Pediatric retinal photograph (wide-field). 1440 by 1080 pixels.
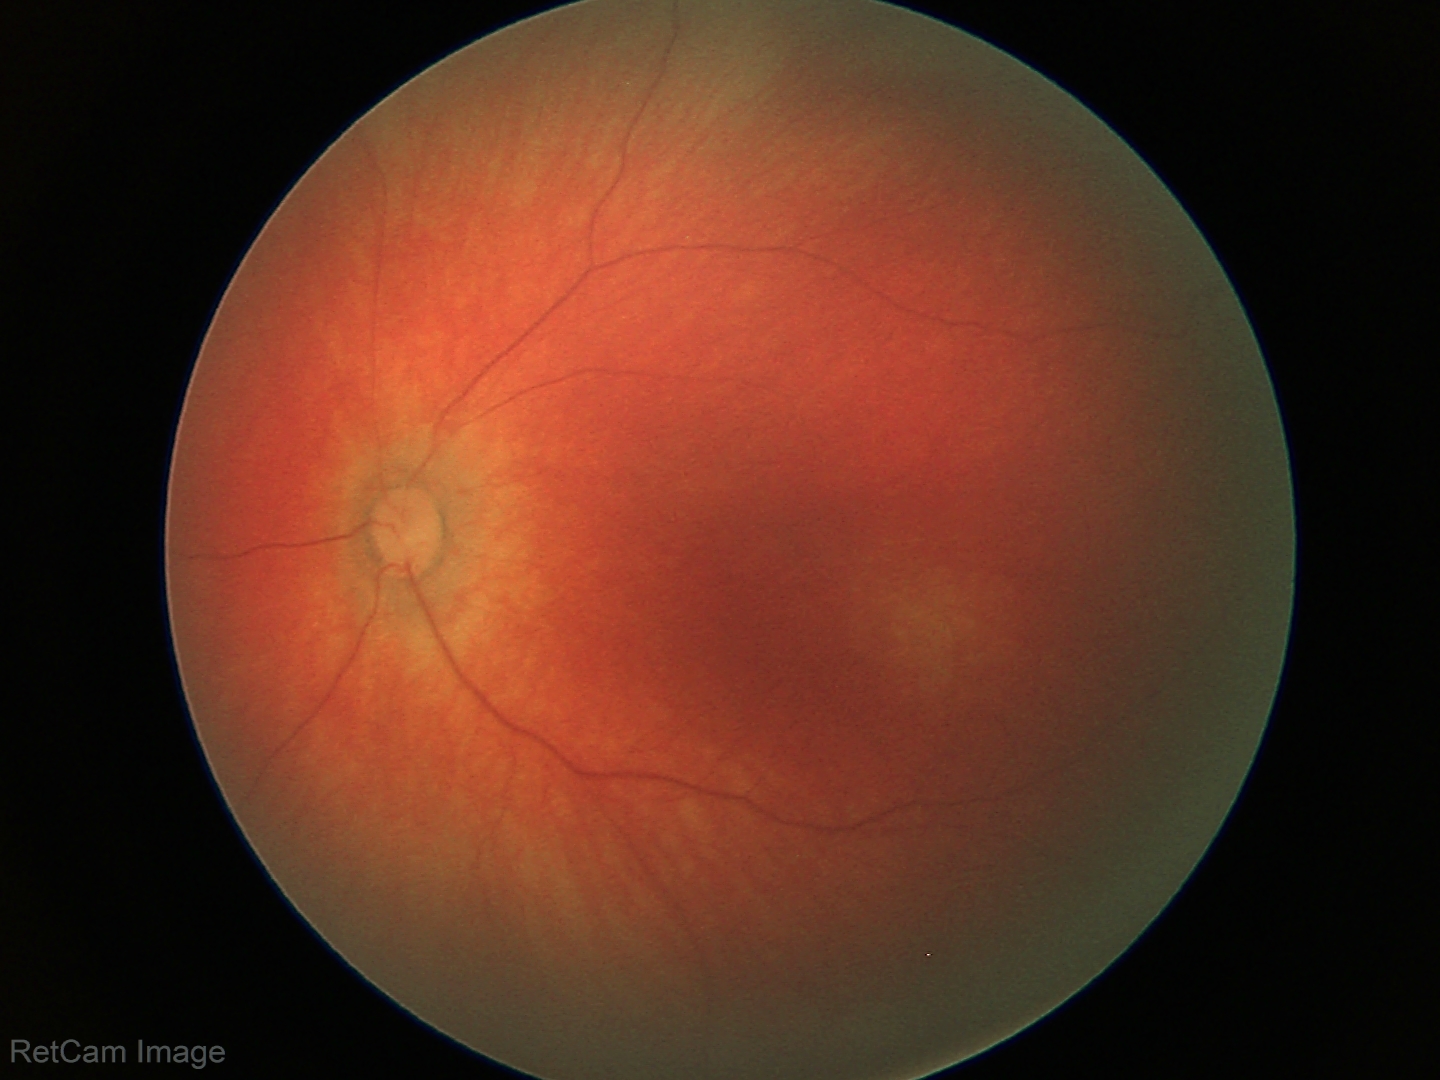

Screening examination diagnosed as physiological.